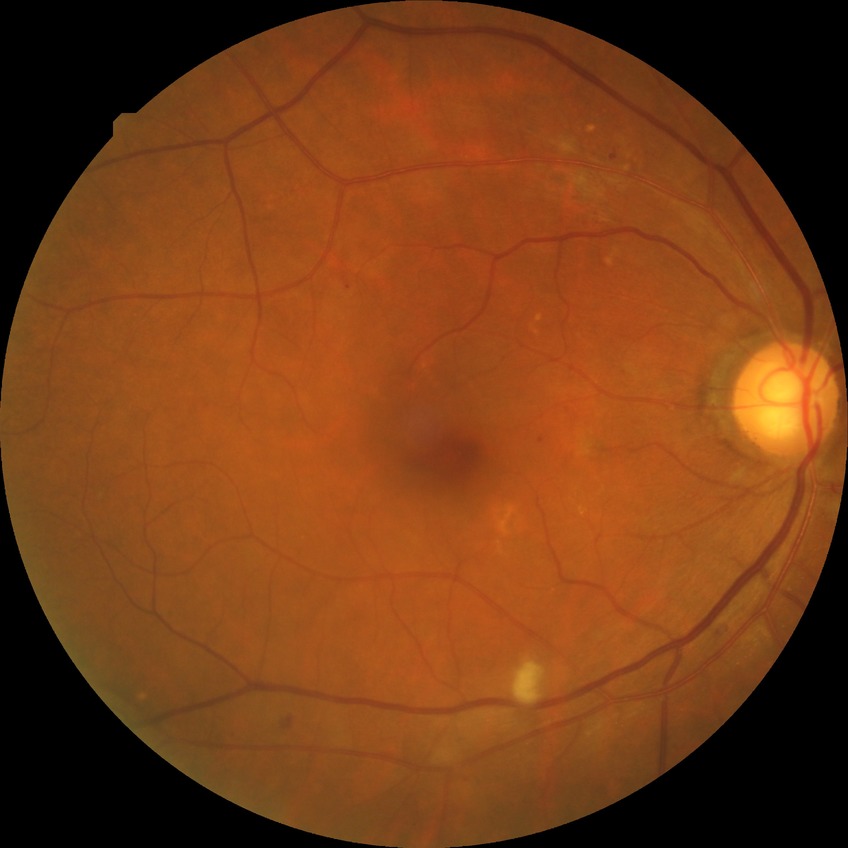 DR stage: PPDR.